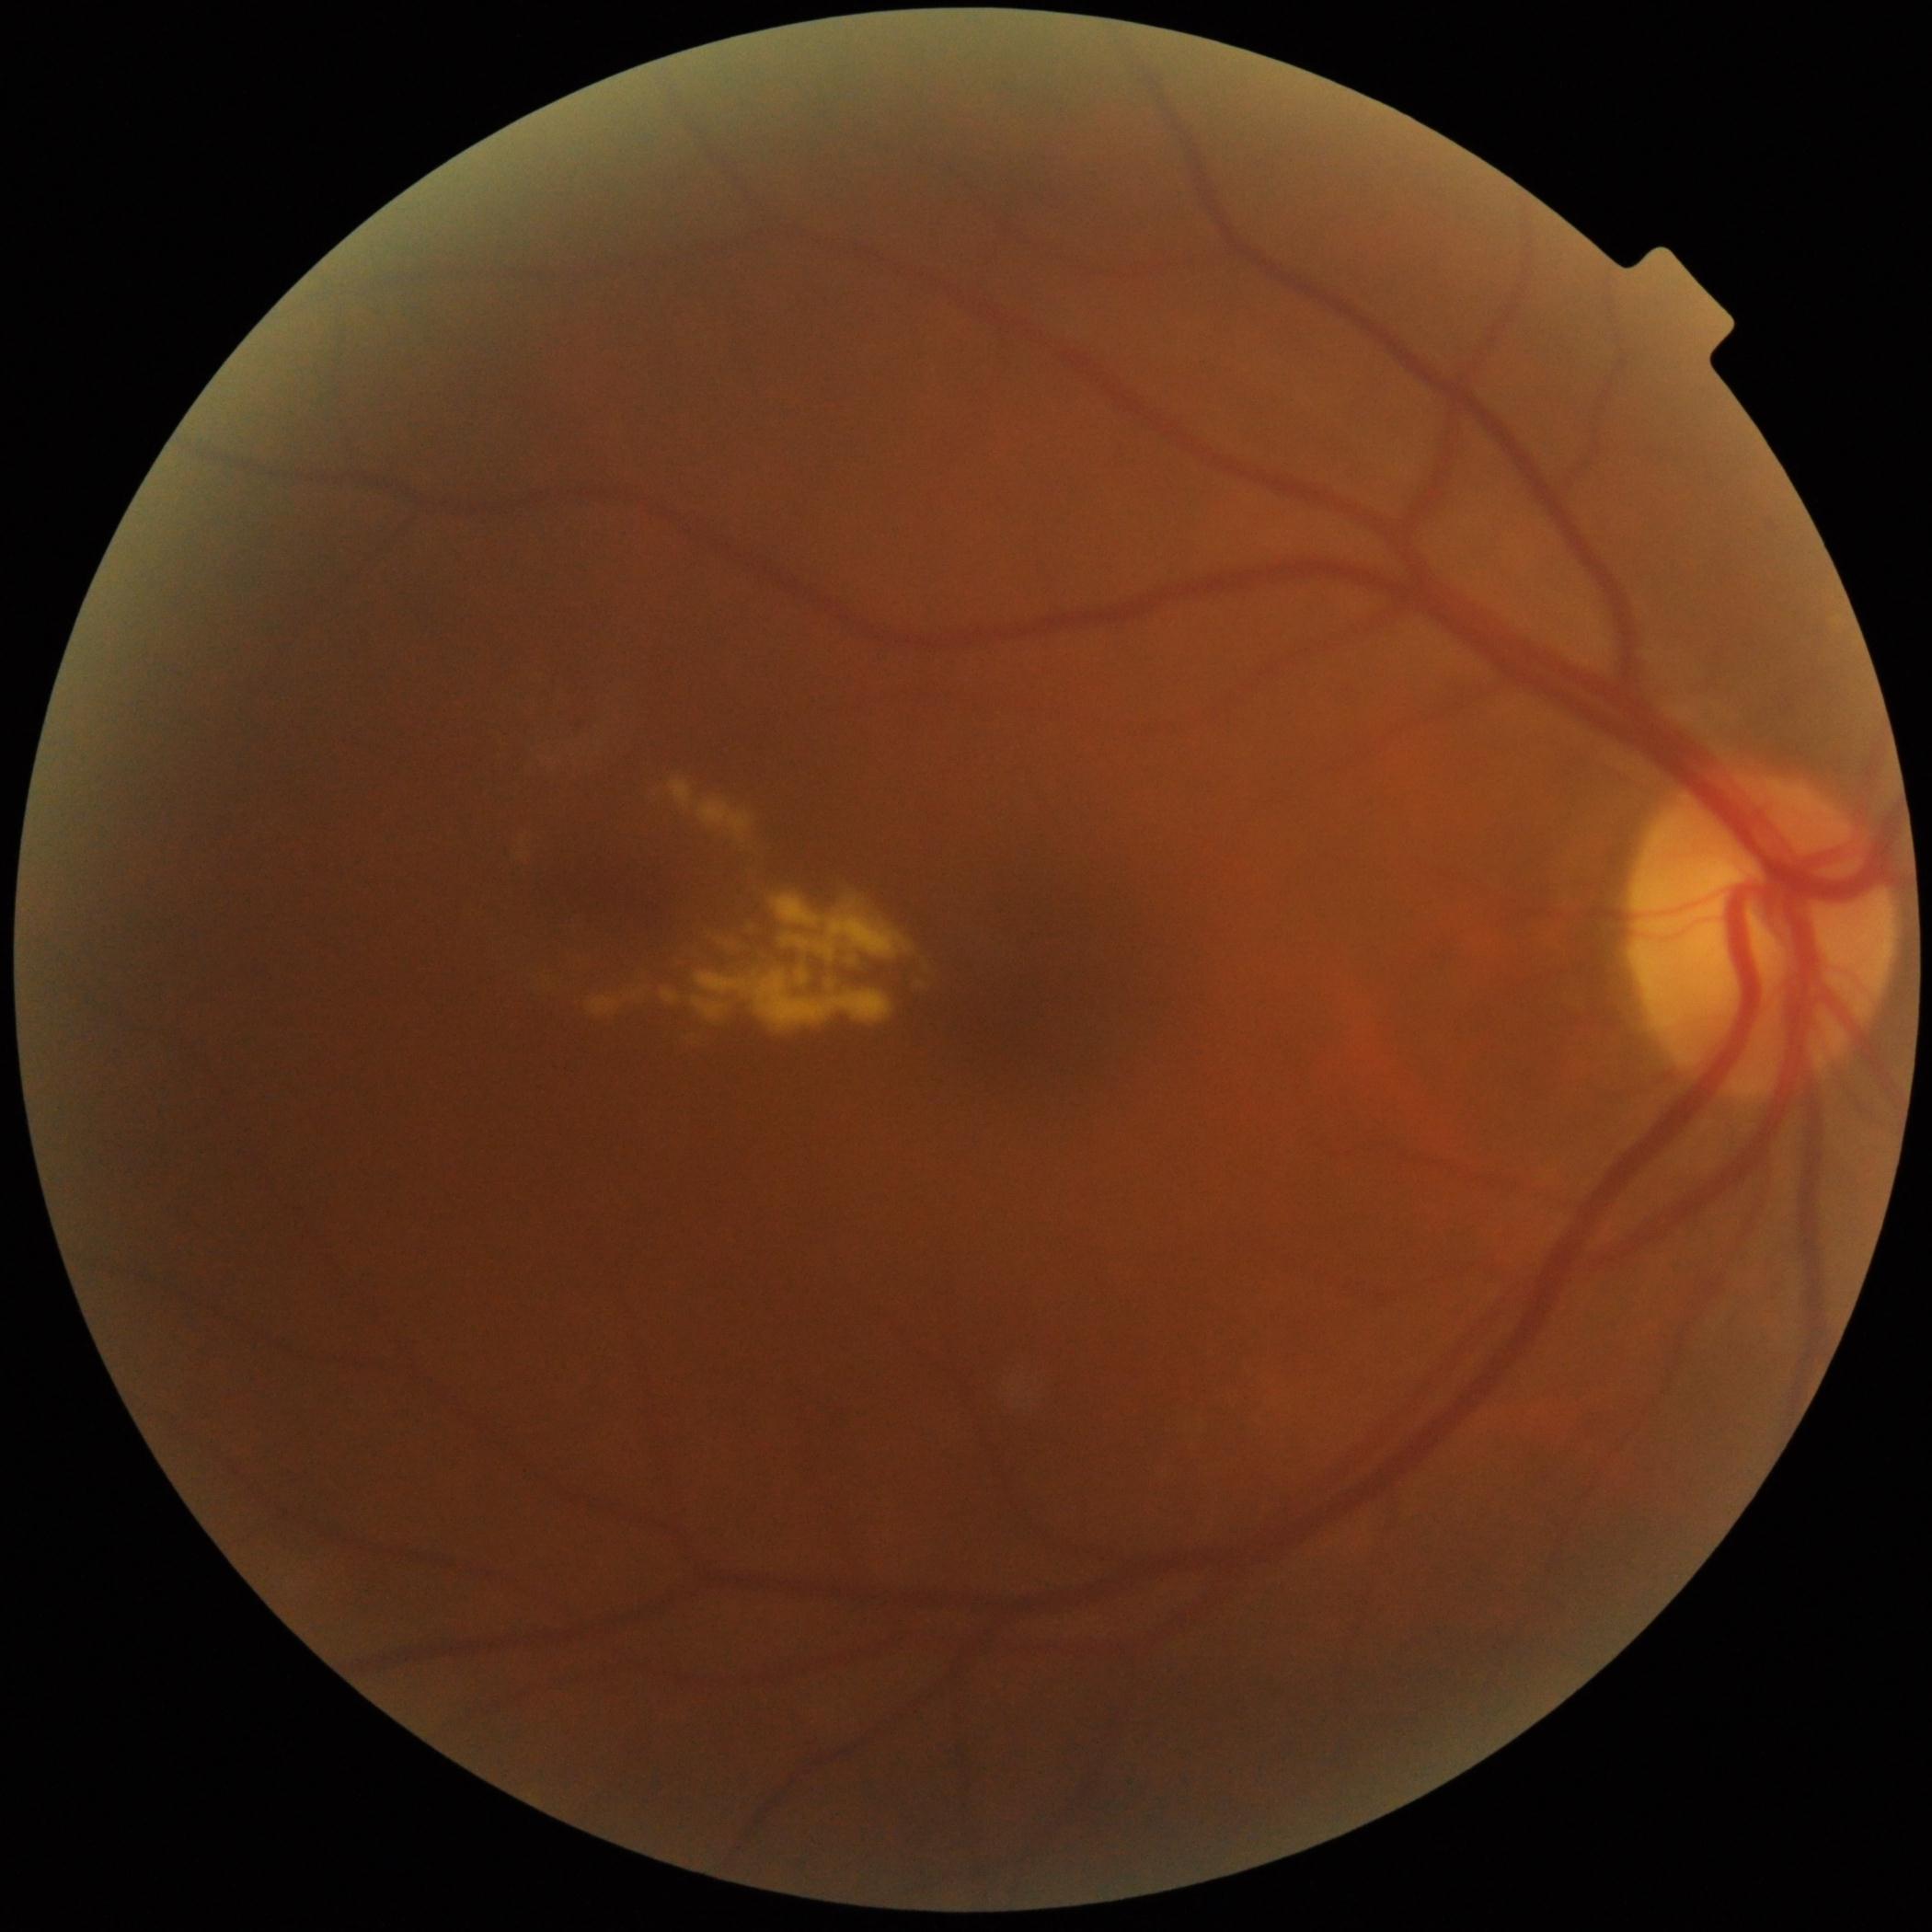 Diabetic retinopathy (DR): 2; non-proliferative diabetic retinopathy
microaneurysms (MAs): (x1=573, y1=716, x2=593, y2=733)
hard exudates (EXs): (x1=633, y1=990, x2=648, y2=997); (x1=670, y1=779, x2=755, y2=845); (x1=907, y1=958, x2=935, y2=988); (x1=515, y1=834, x2=532, y2=865); (x1=857, y1=887, x2=888, y2=917); (x1=683, y1=915, x2=773, y2=966); (x1=693, y1=995, x2=728, y2=1019); (x1=748, y1=876, x2=913, y2=979); (x1=590, y1=997, x2=620, y2=1016); (x1=797, y1=970, x2=810, y2=986); (x1=696, y1=972, x2=893, y2=1030); (x1=535, y1=967, x2=555, y2=992); (x1=662, y1=988, x2=681, y2=1005)
Smaller EXs around [832, 986]; [854, 961]
soft exudates (SEs): not present
hemorrhages (HEs): not present